Image size 2048x1536, 45° FOV
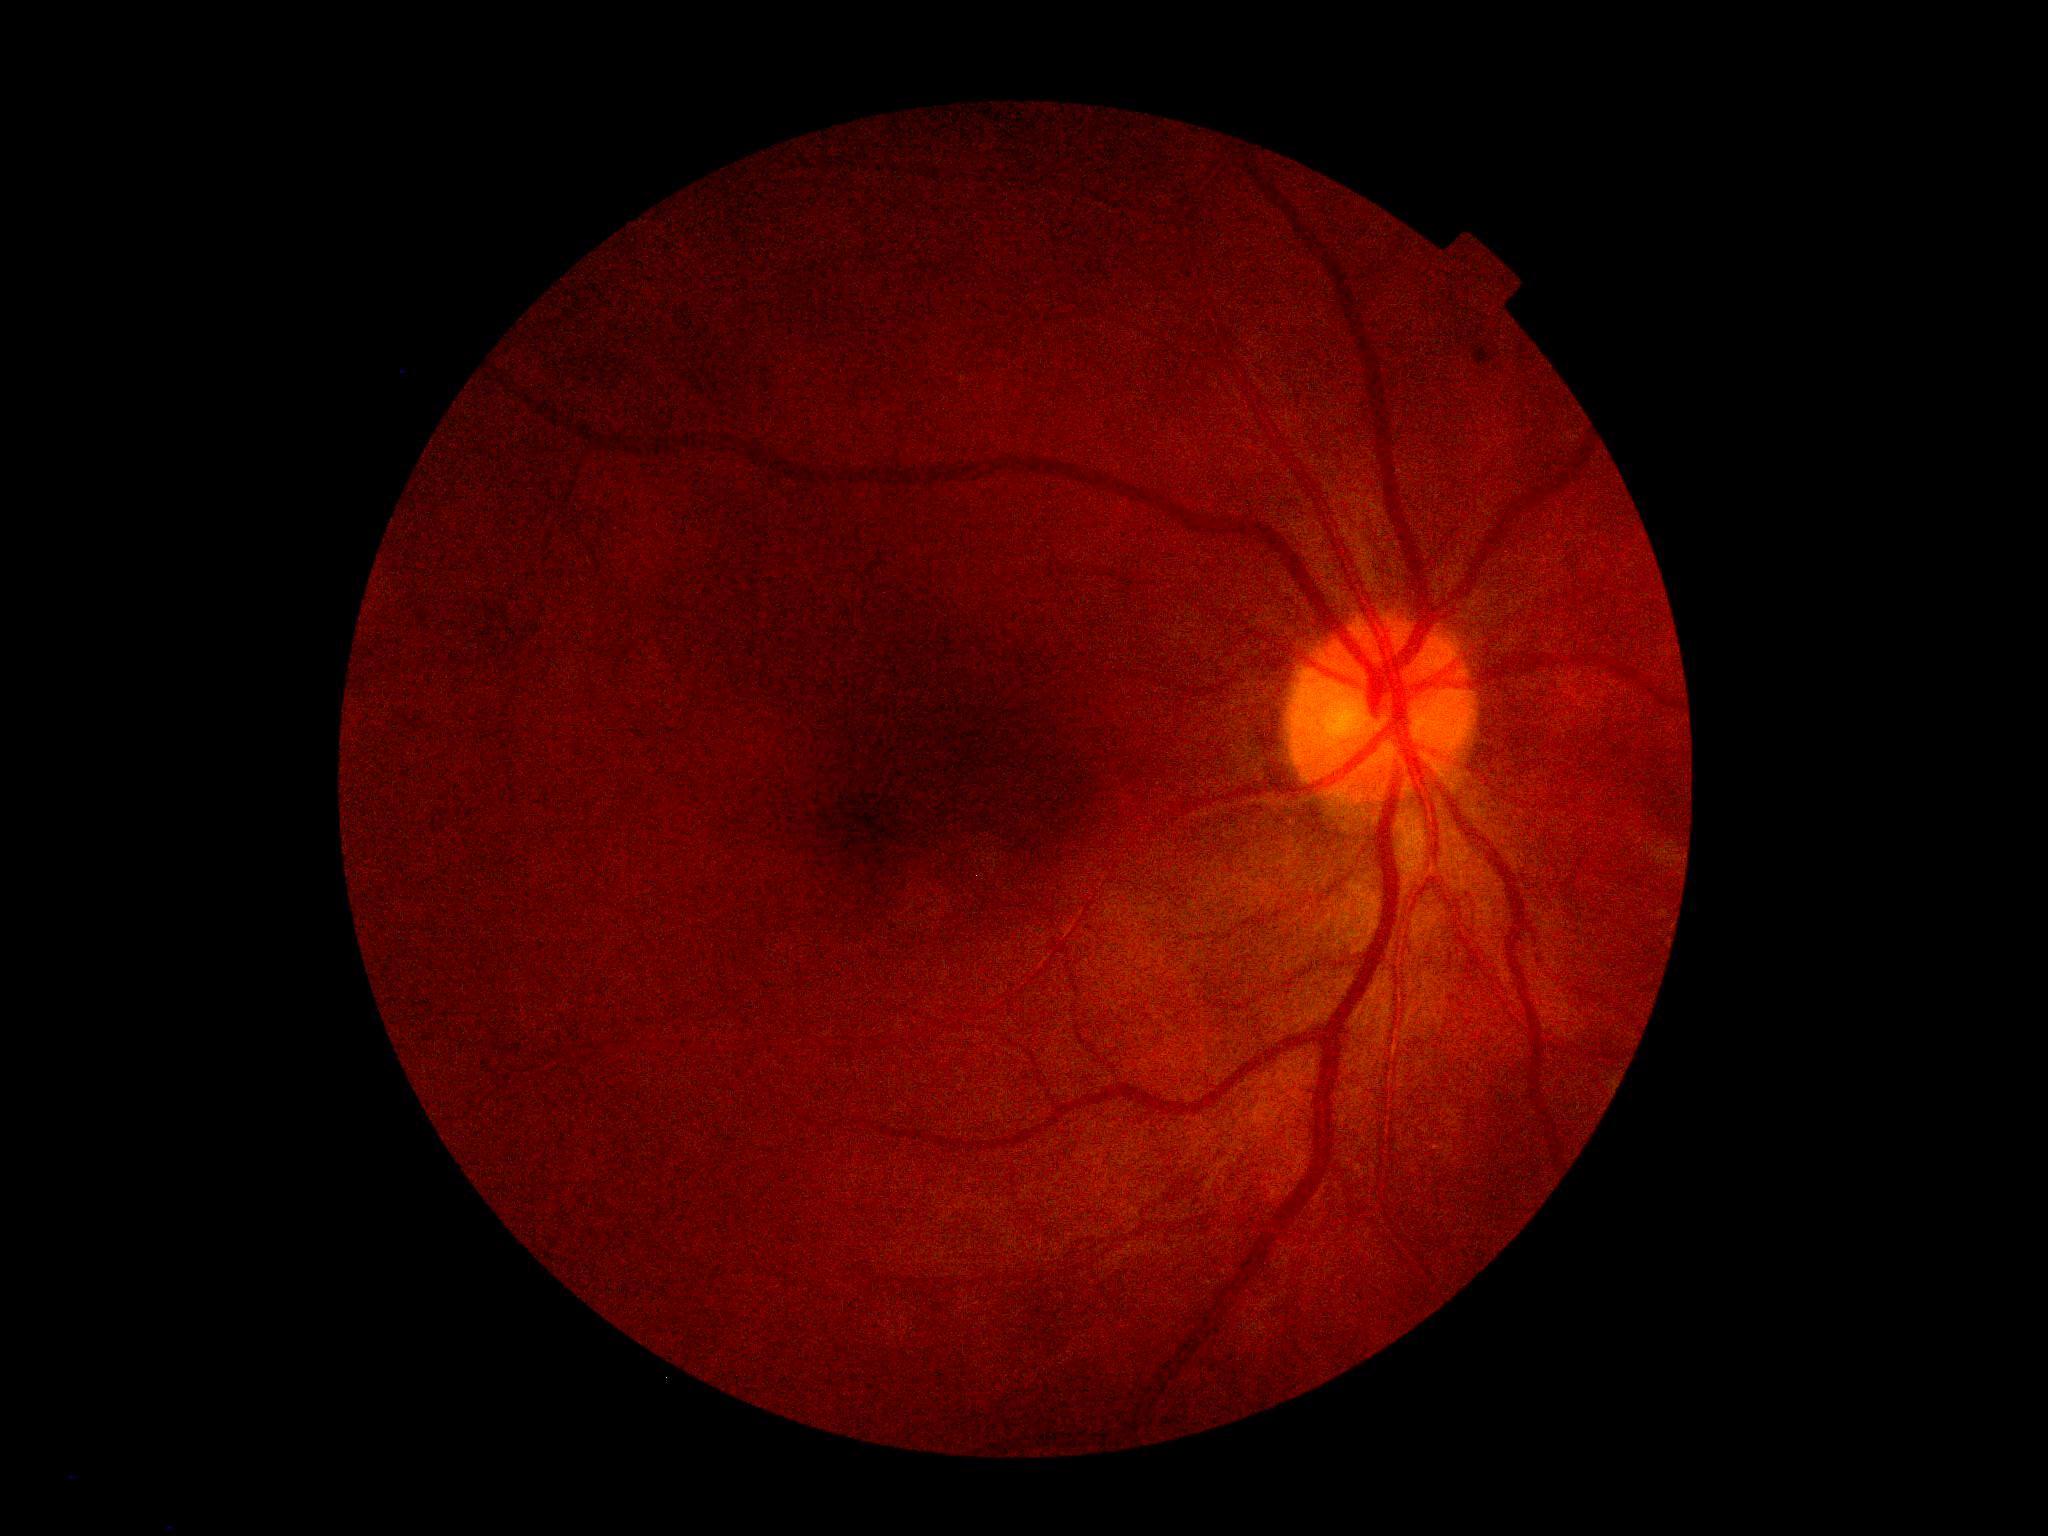

DR class: non-proliferative diabetic retinopathy, diabetic retinopathy (DR): grade 2 (moderate NPDR).